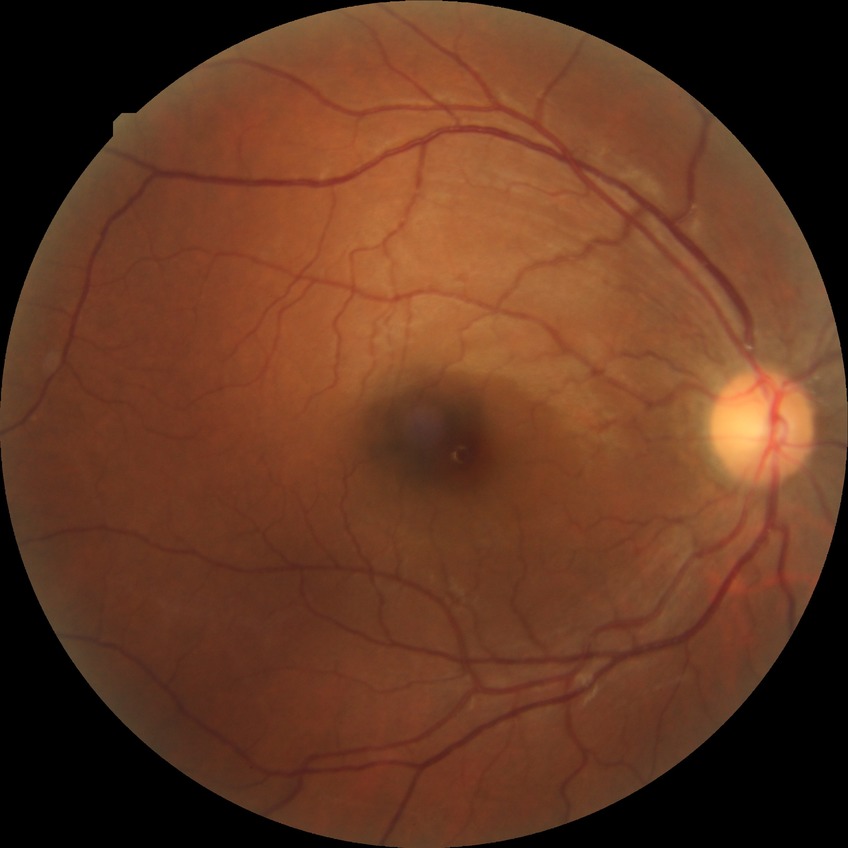

Modified Davis classification: no diabetic retinopathy.